1932 by 1910 pixels.
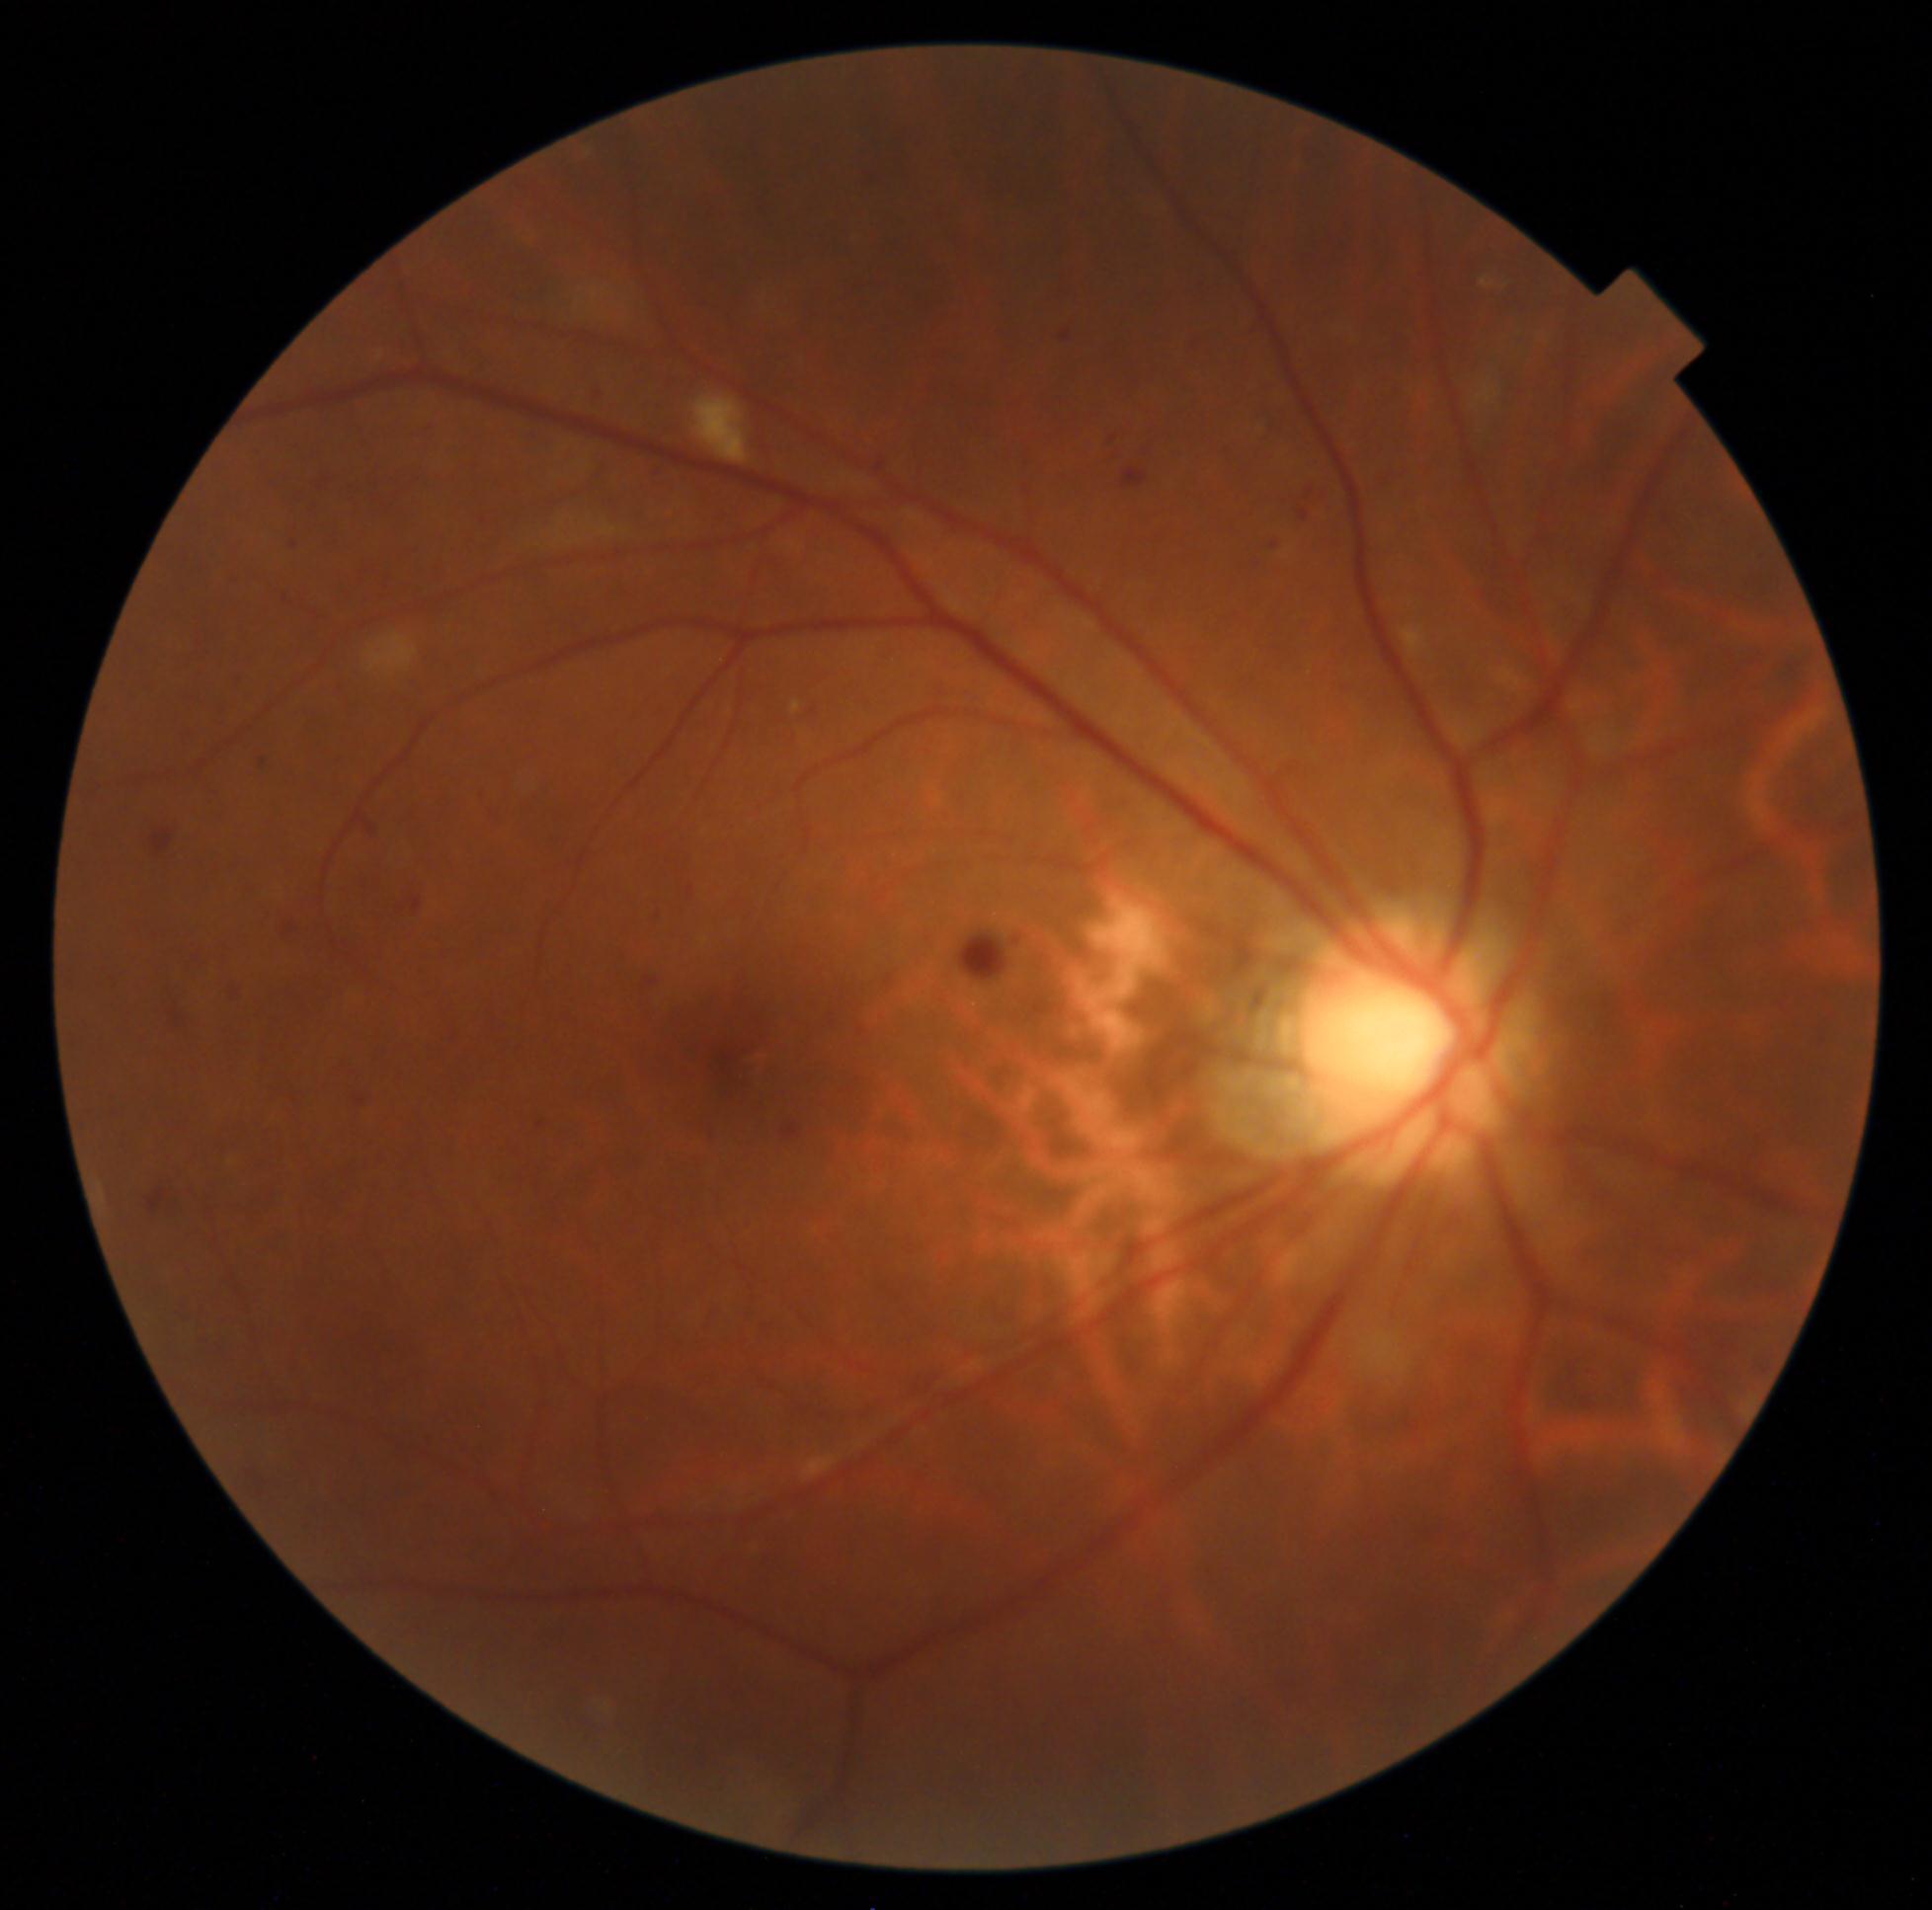 retinopathy grade: 2
DR class: non-proliferative diabetic retinopathy